RetCam wide-field infant fundus image
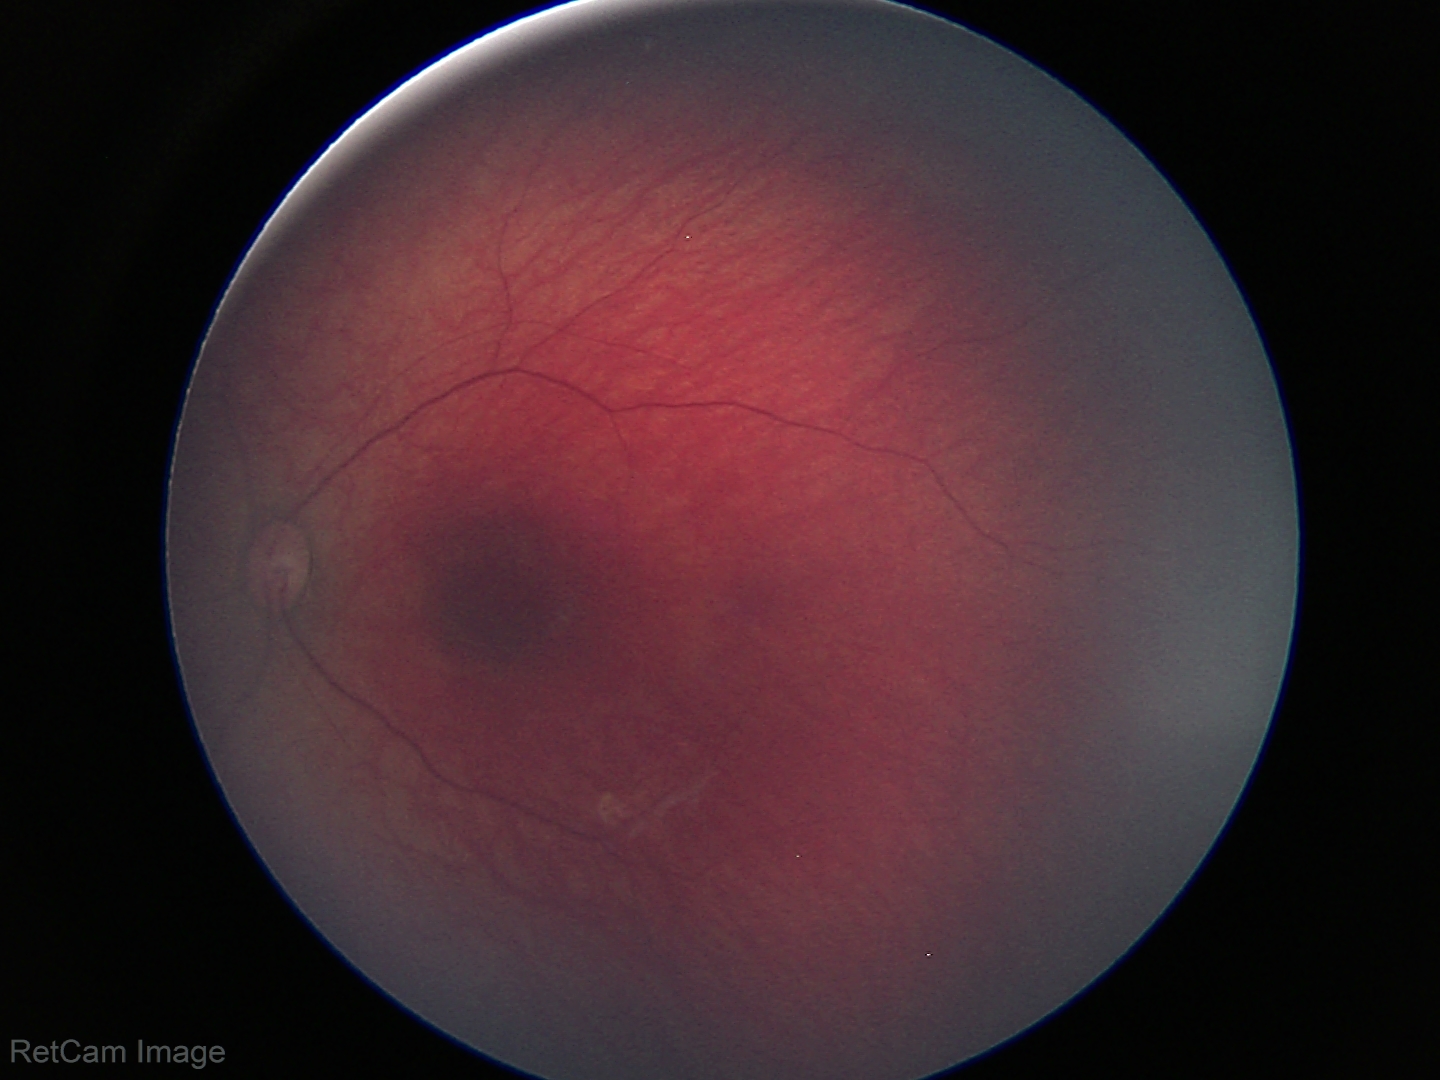 Physiological retinal appearance for postconceptual age.